2352x1568.
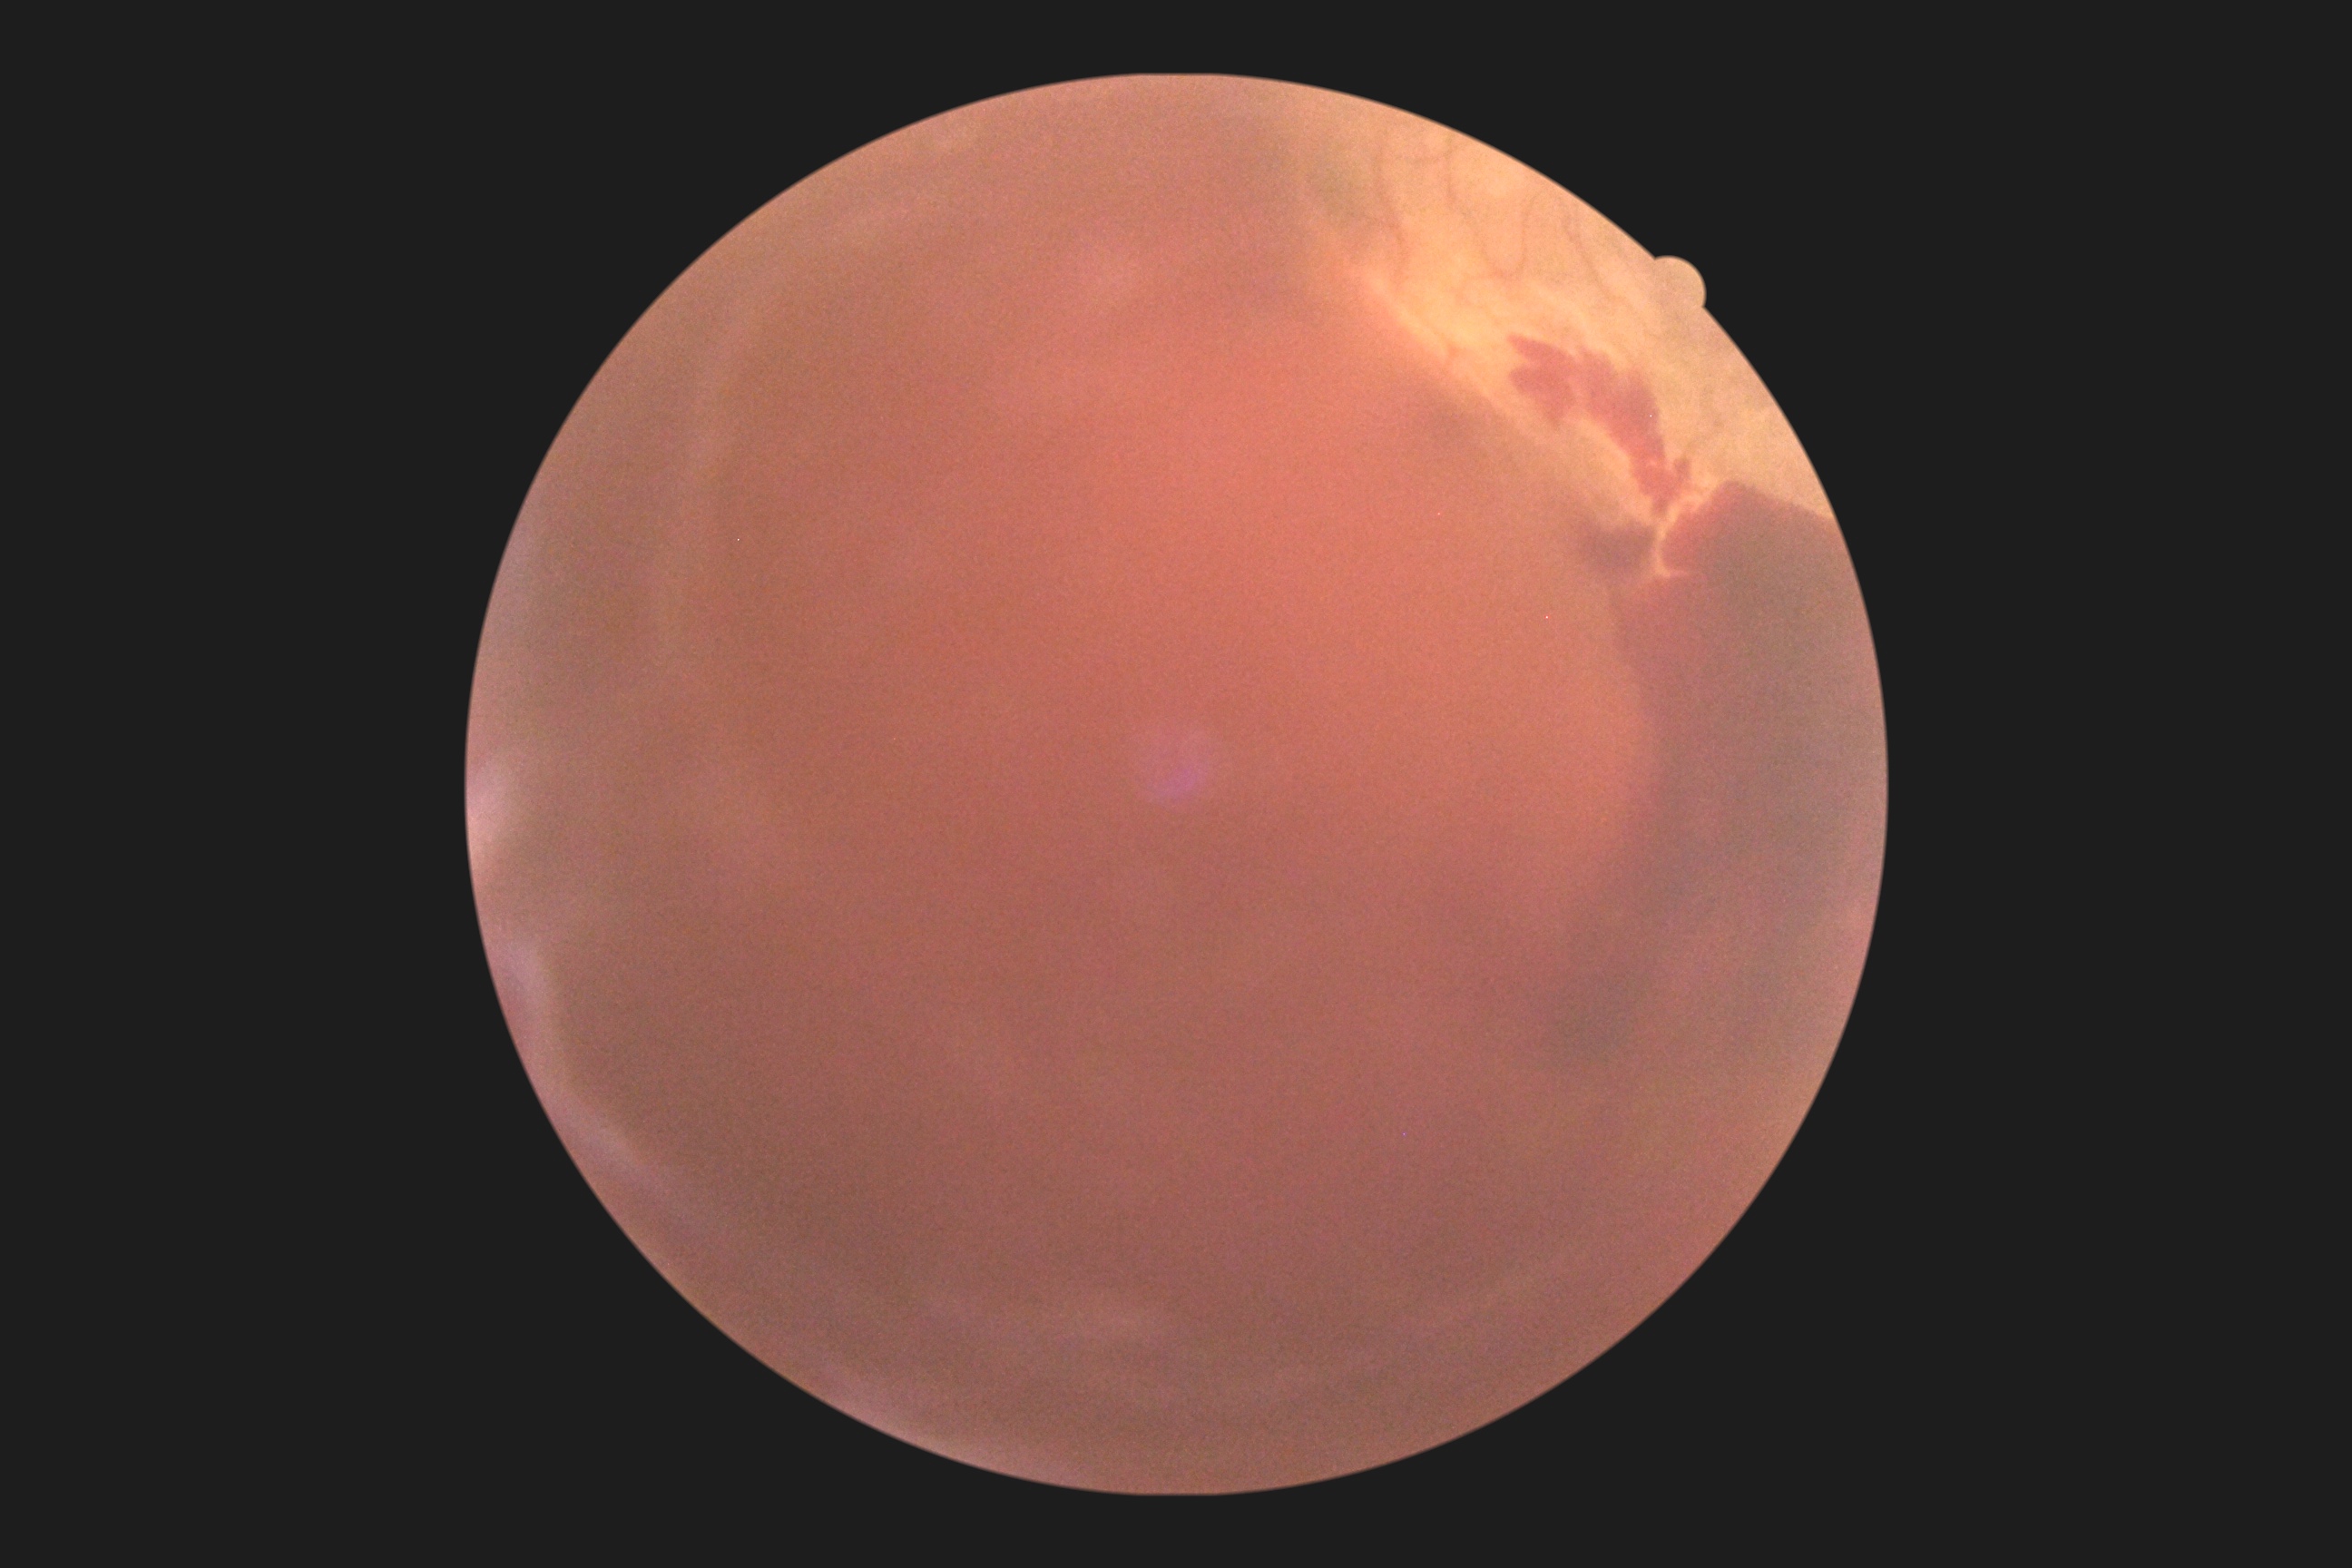

Diabetic retinopathy severity is proliferative diabetic retinopathy (grade 4).